Retinal fundus photograph — 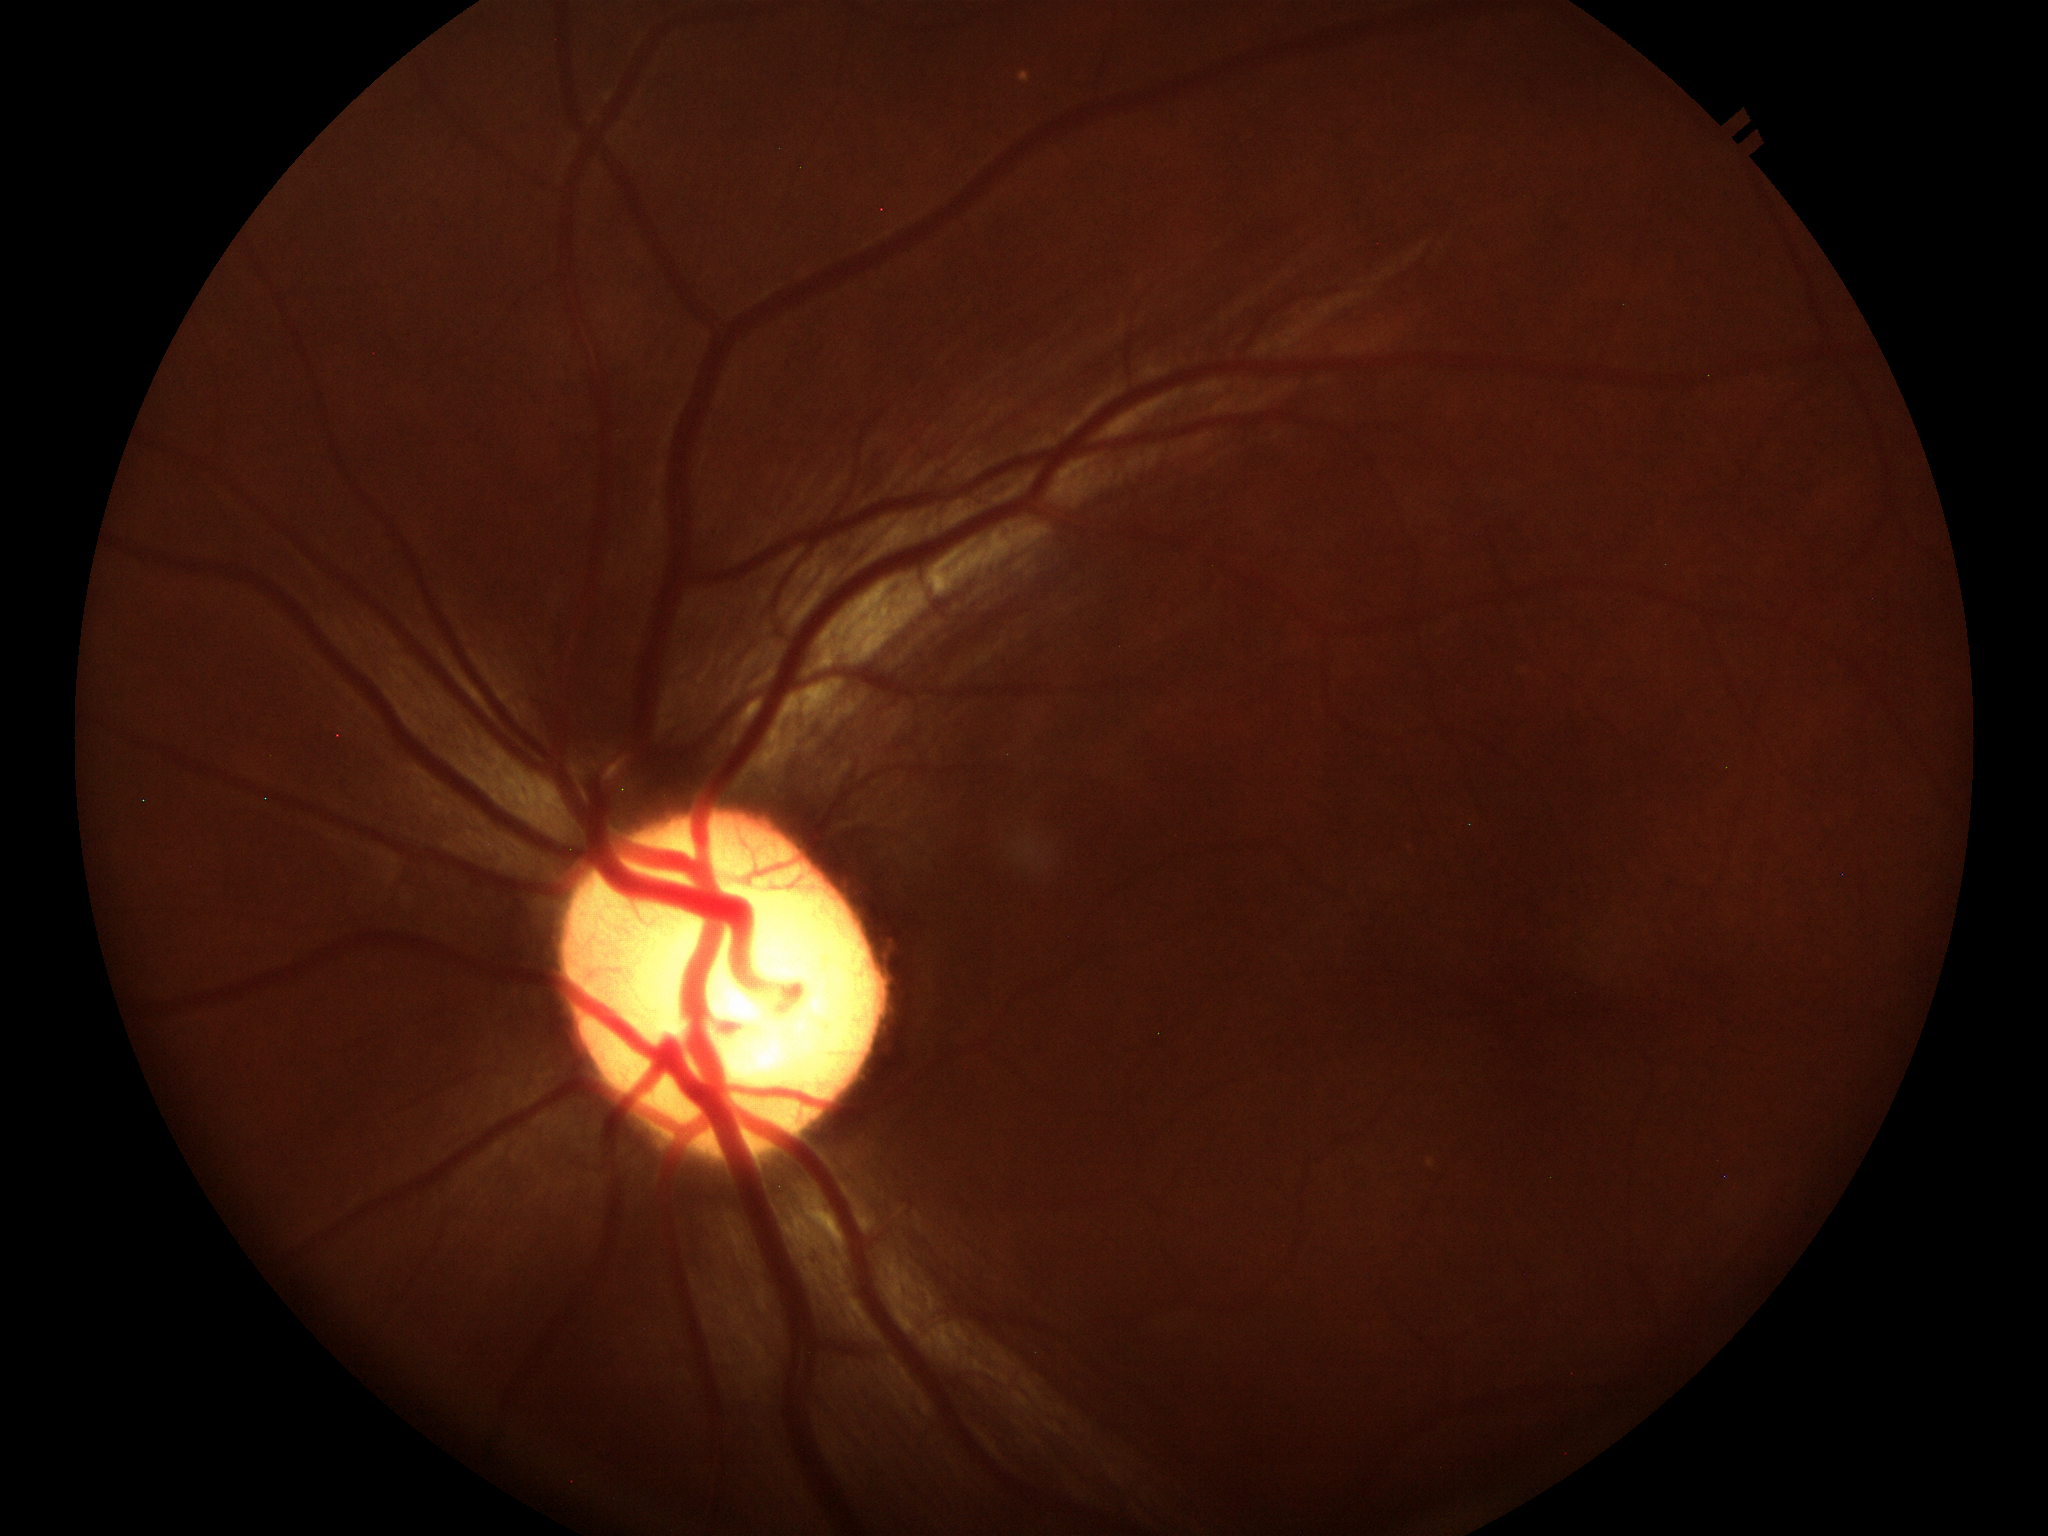   glaucoma_decision: suspect
  vcdr: 0.57
  hcdr: 0.58